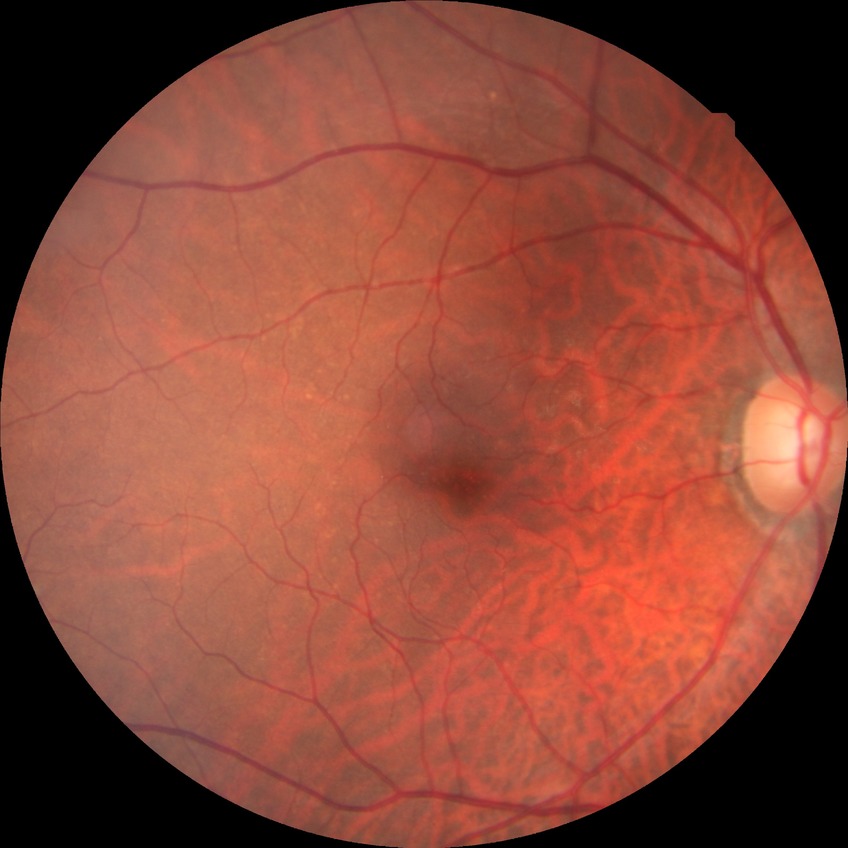

Retinopathy stage is no diabetic retinopathy.